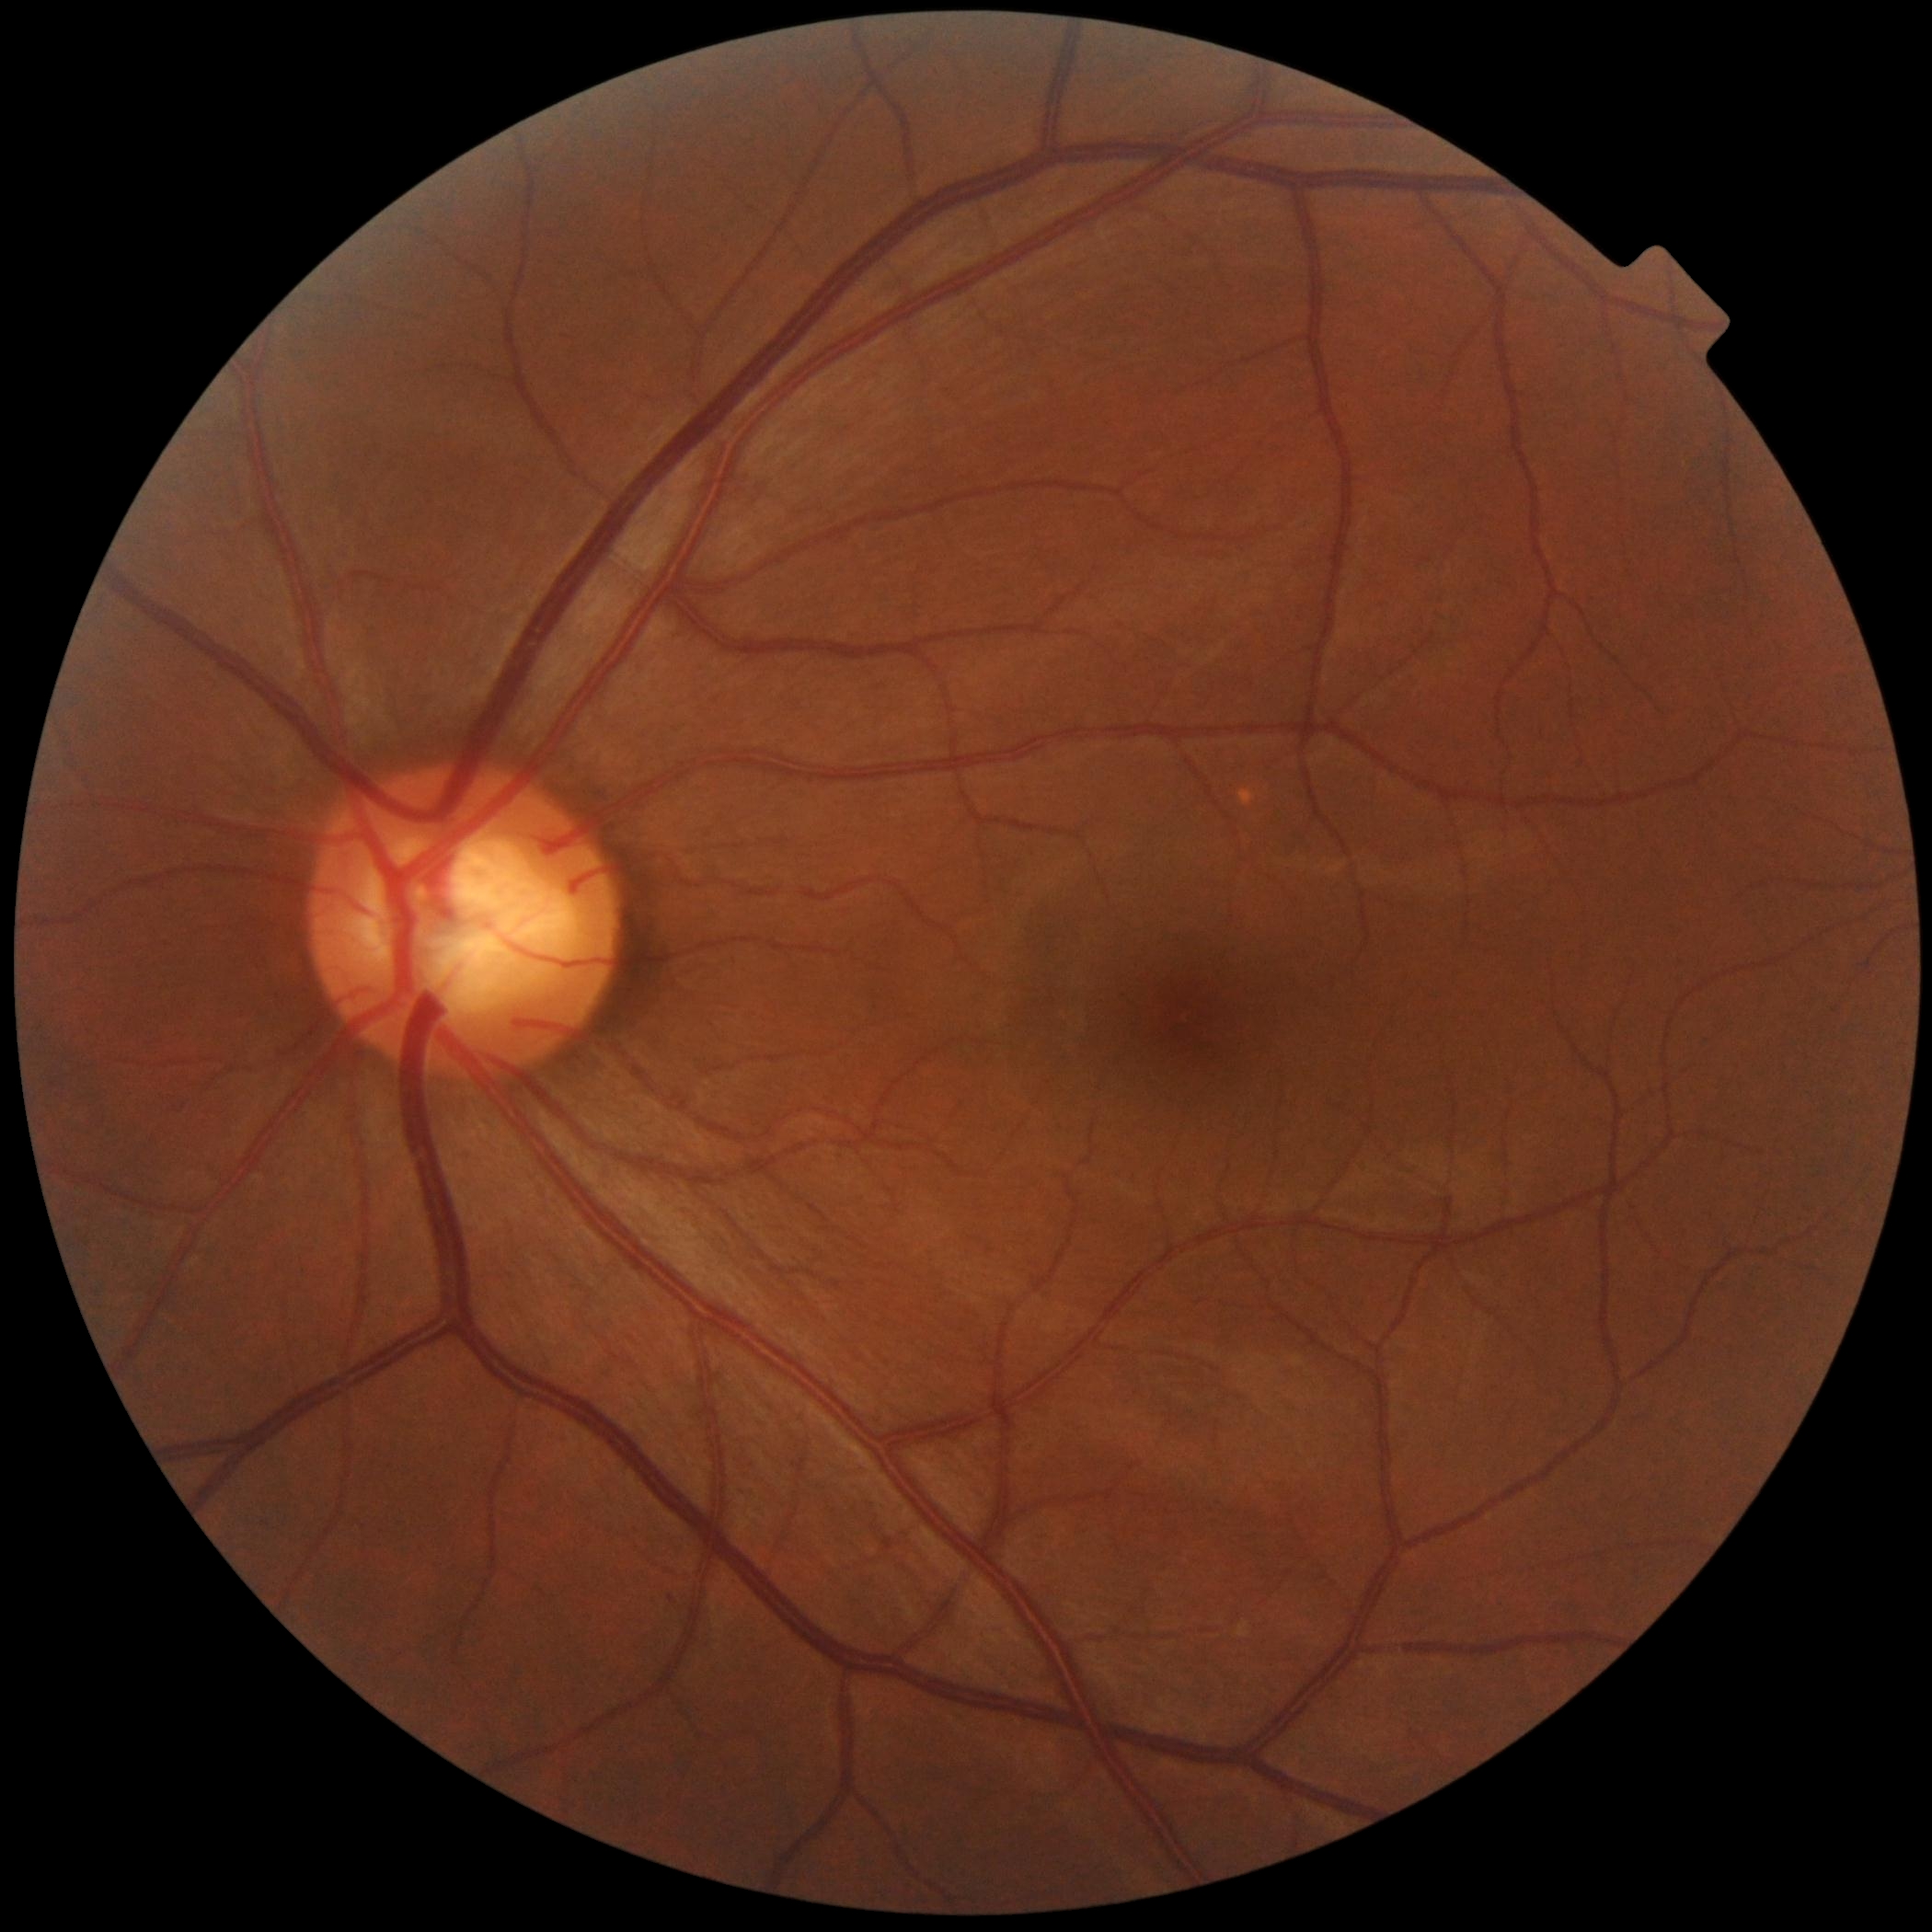

DR severity is 0.